Wide-field contact fundus photograph of an infant.
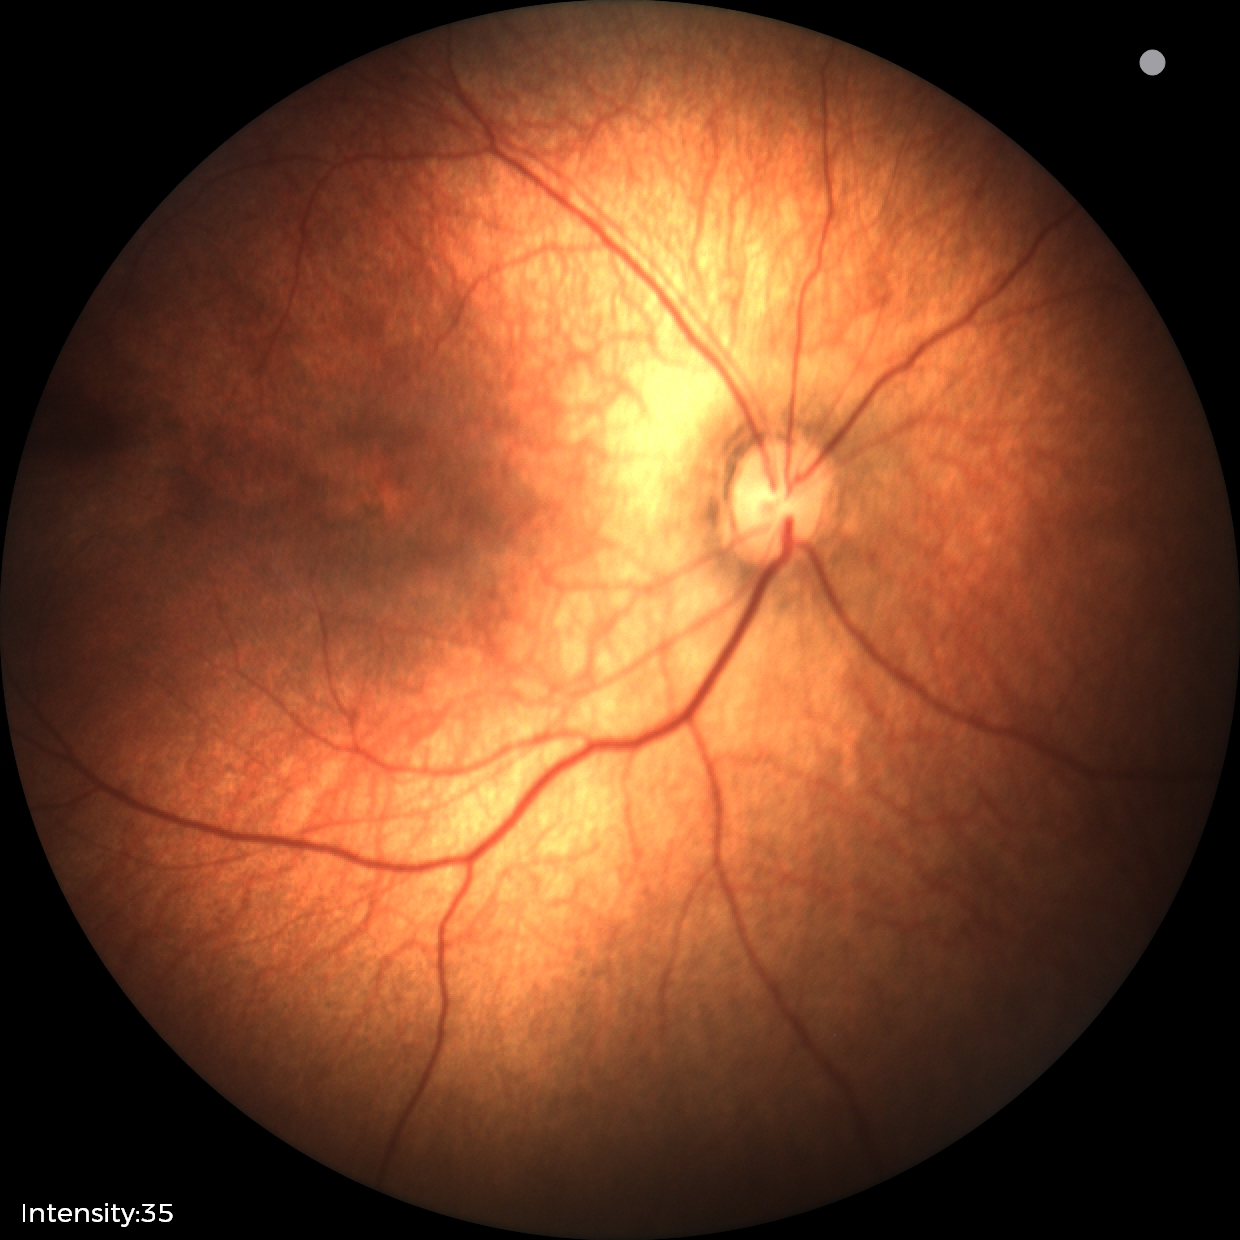 Examination with physiological retinal findings.